1932x1932; FOV: 45 degrees
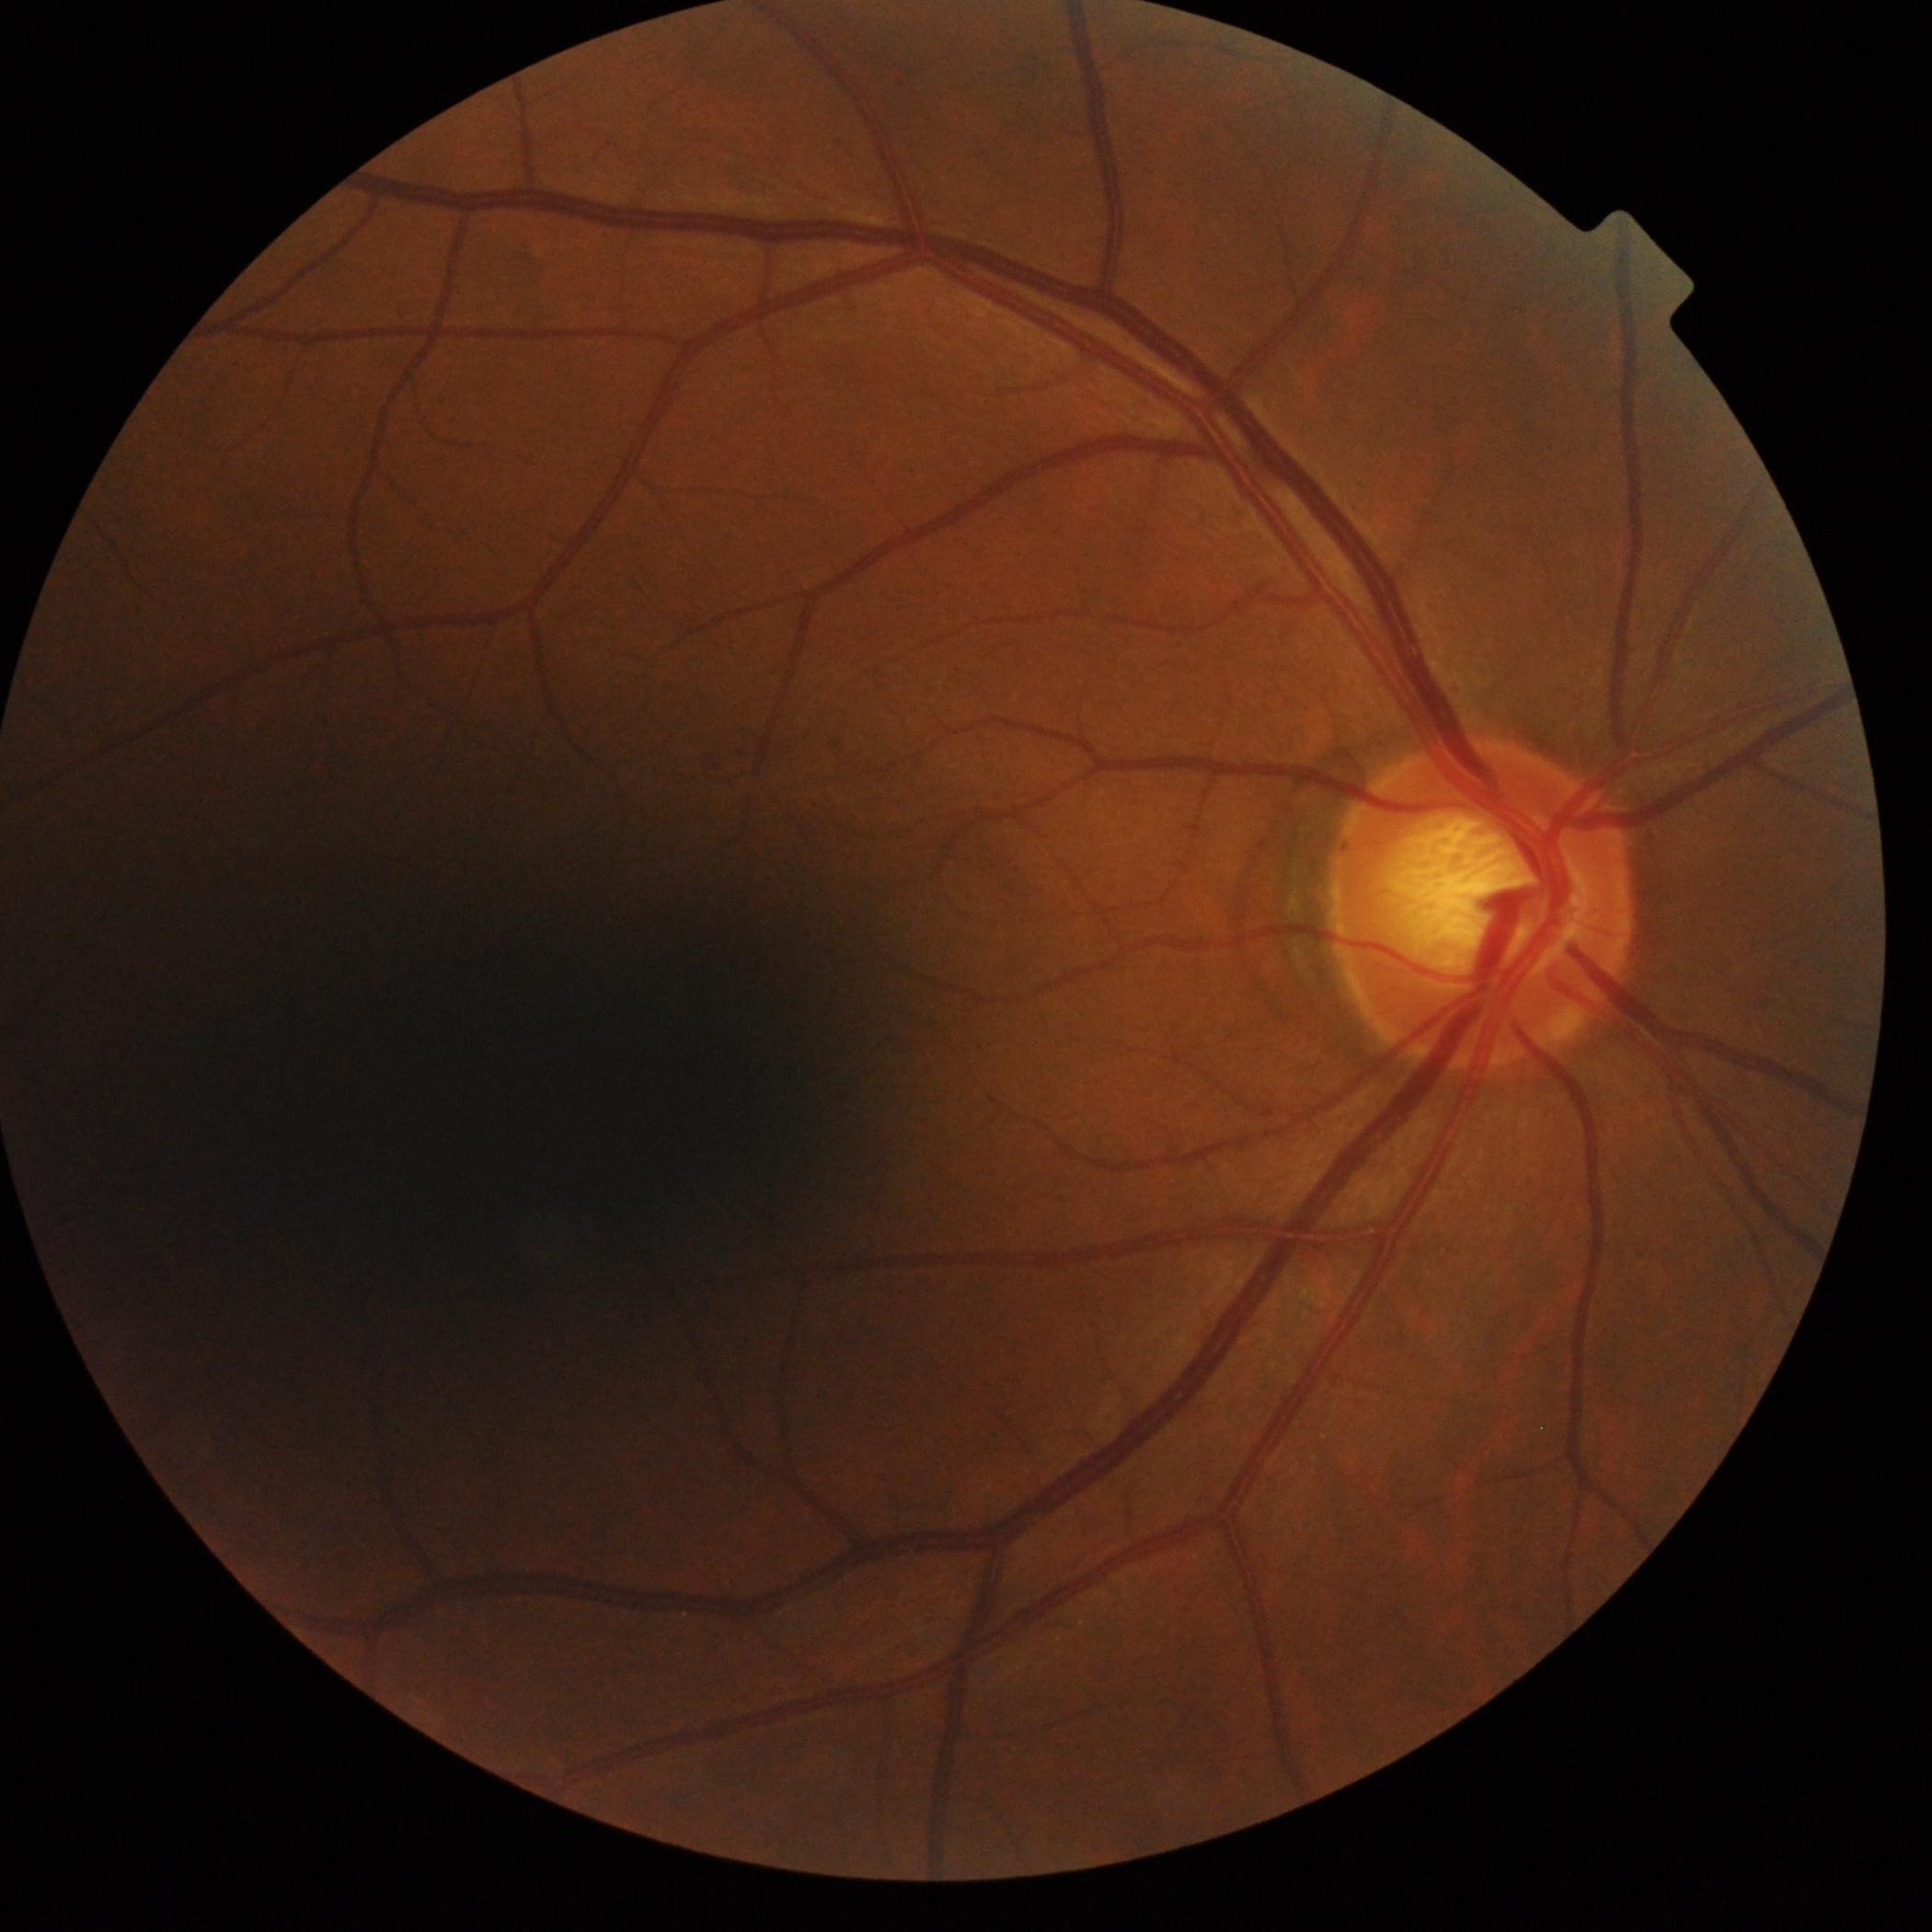 Findings:
• DR impression — no apparent DR
• diabetic retinopathy severity — grade 0 (no apparent retinopathy)